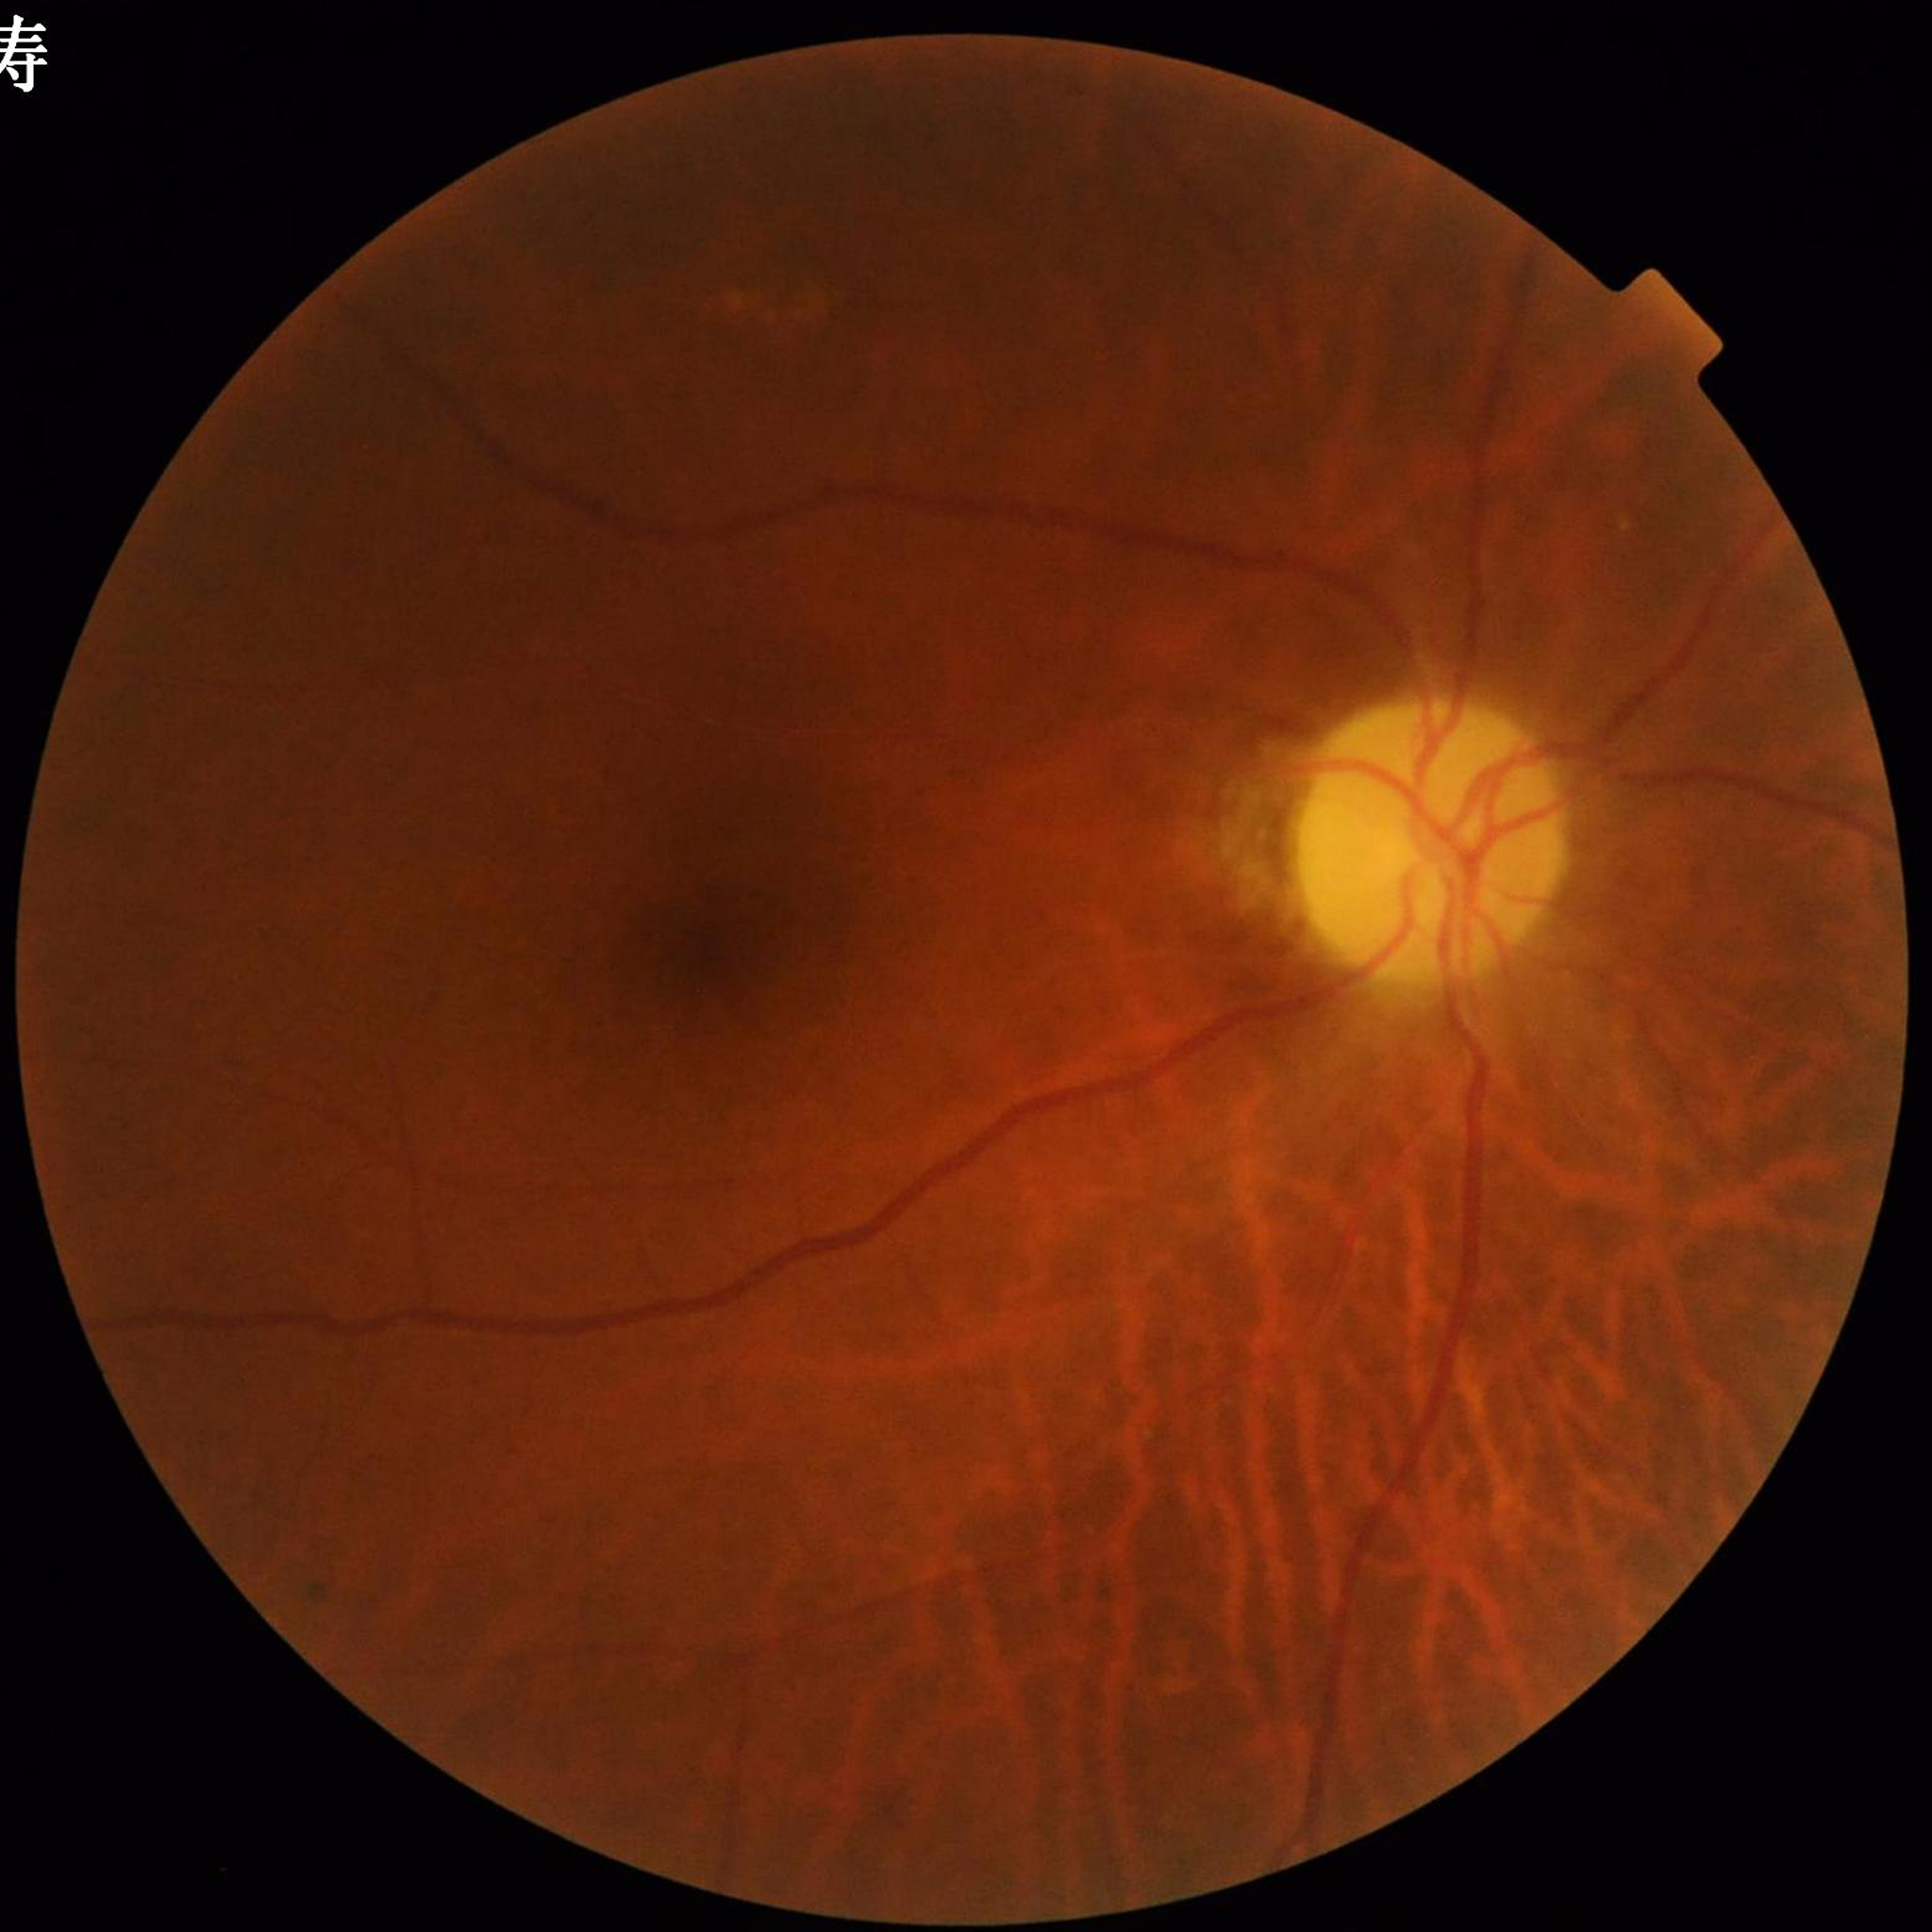 Disease class = diabetic retinopathy
Automated quality assessment = good